Pediatric wide-field fundus photograph; Phoenix ICON, 100° FOV:
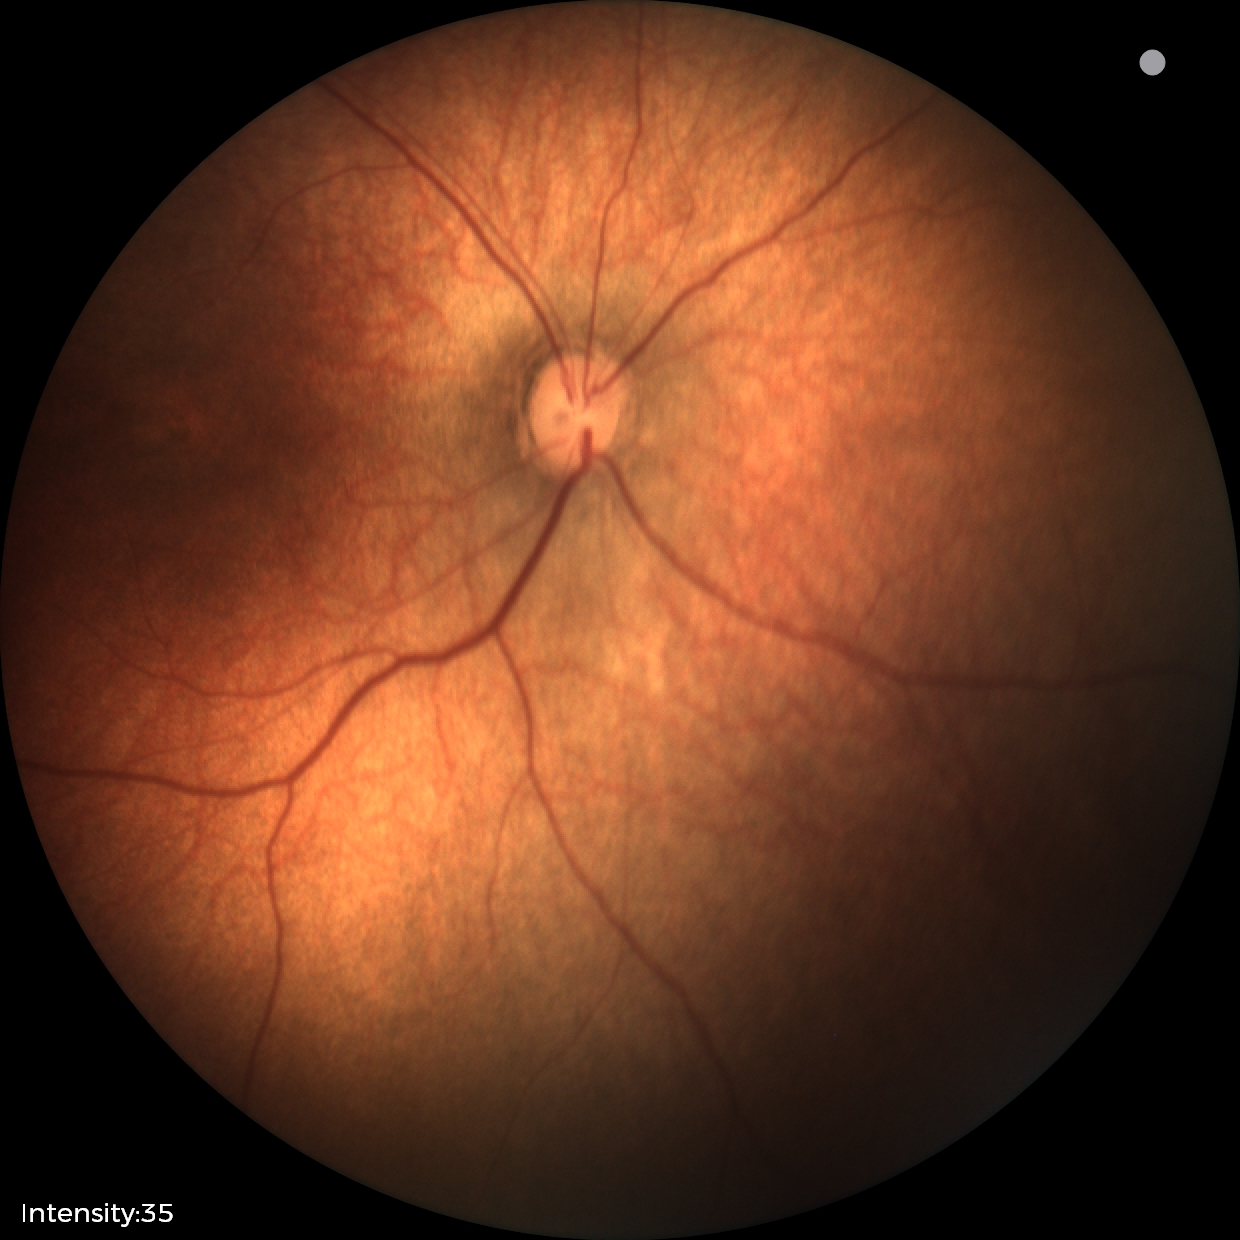
Examination with physiological retinal findings.